CFP. 2212x1659px. 45-degree field of view — 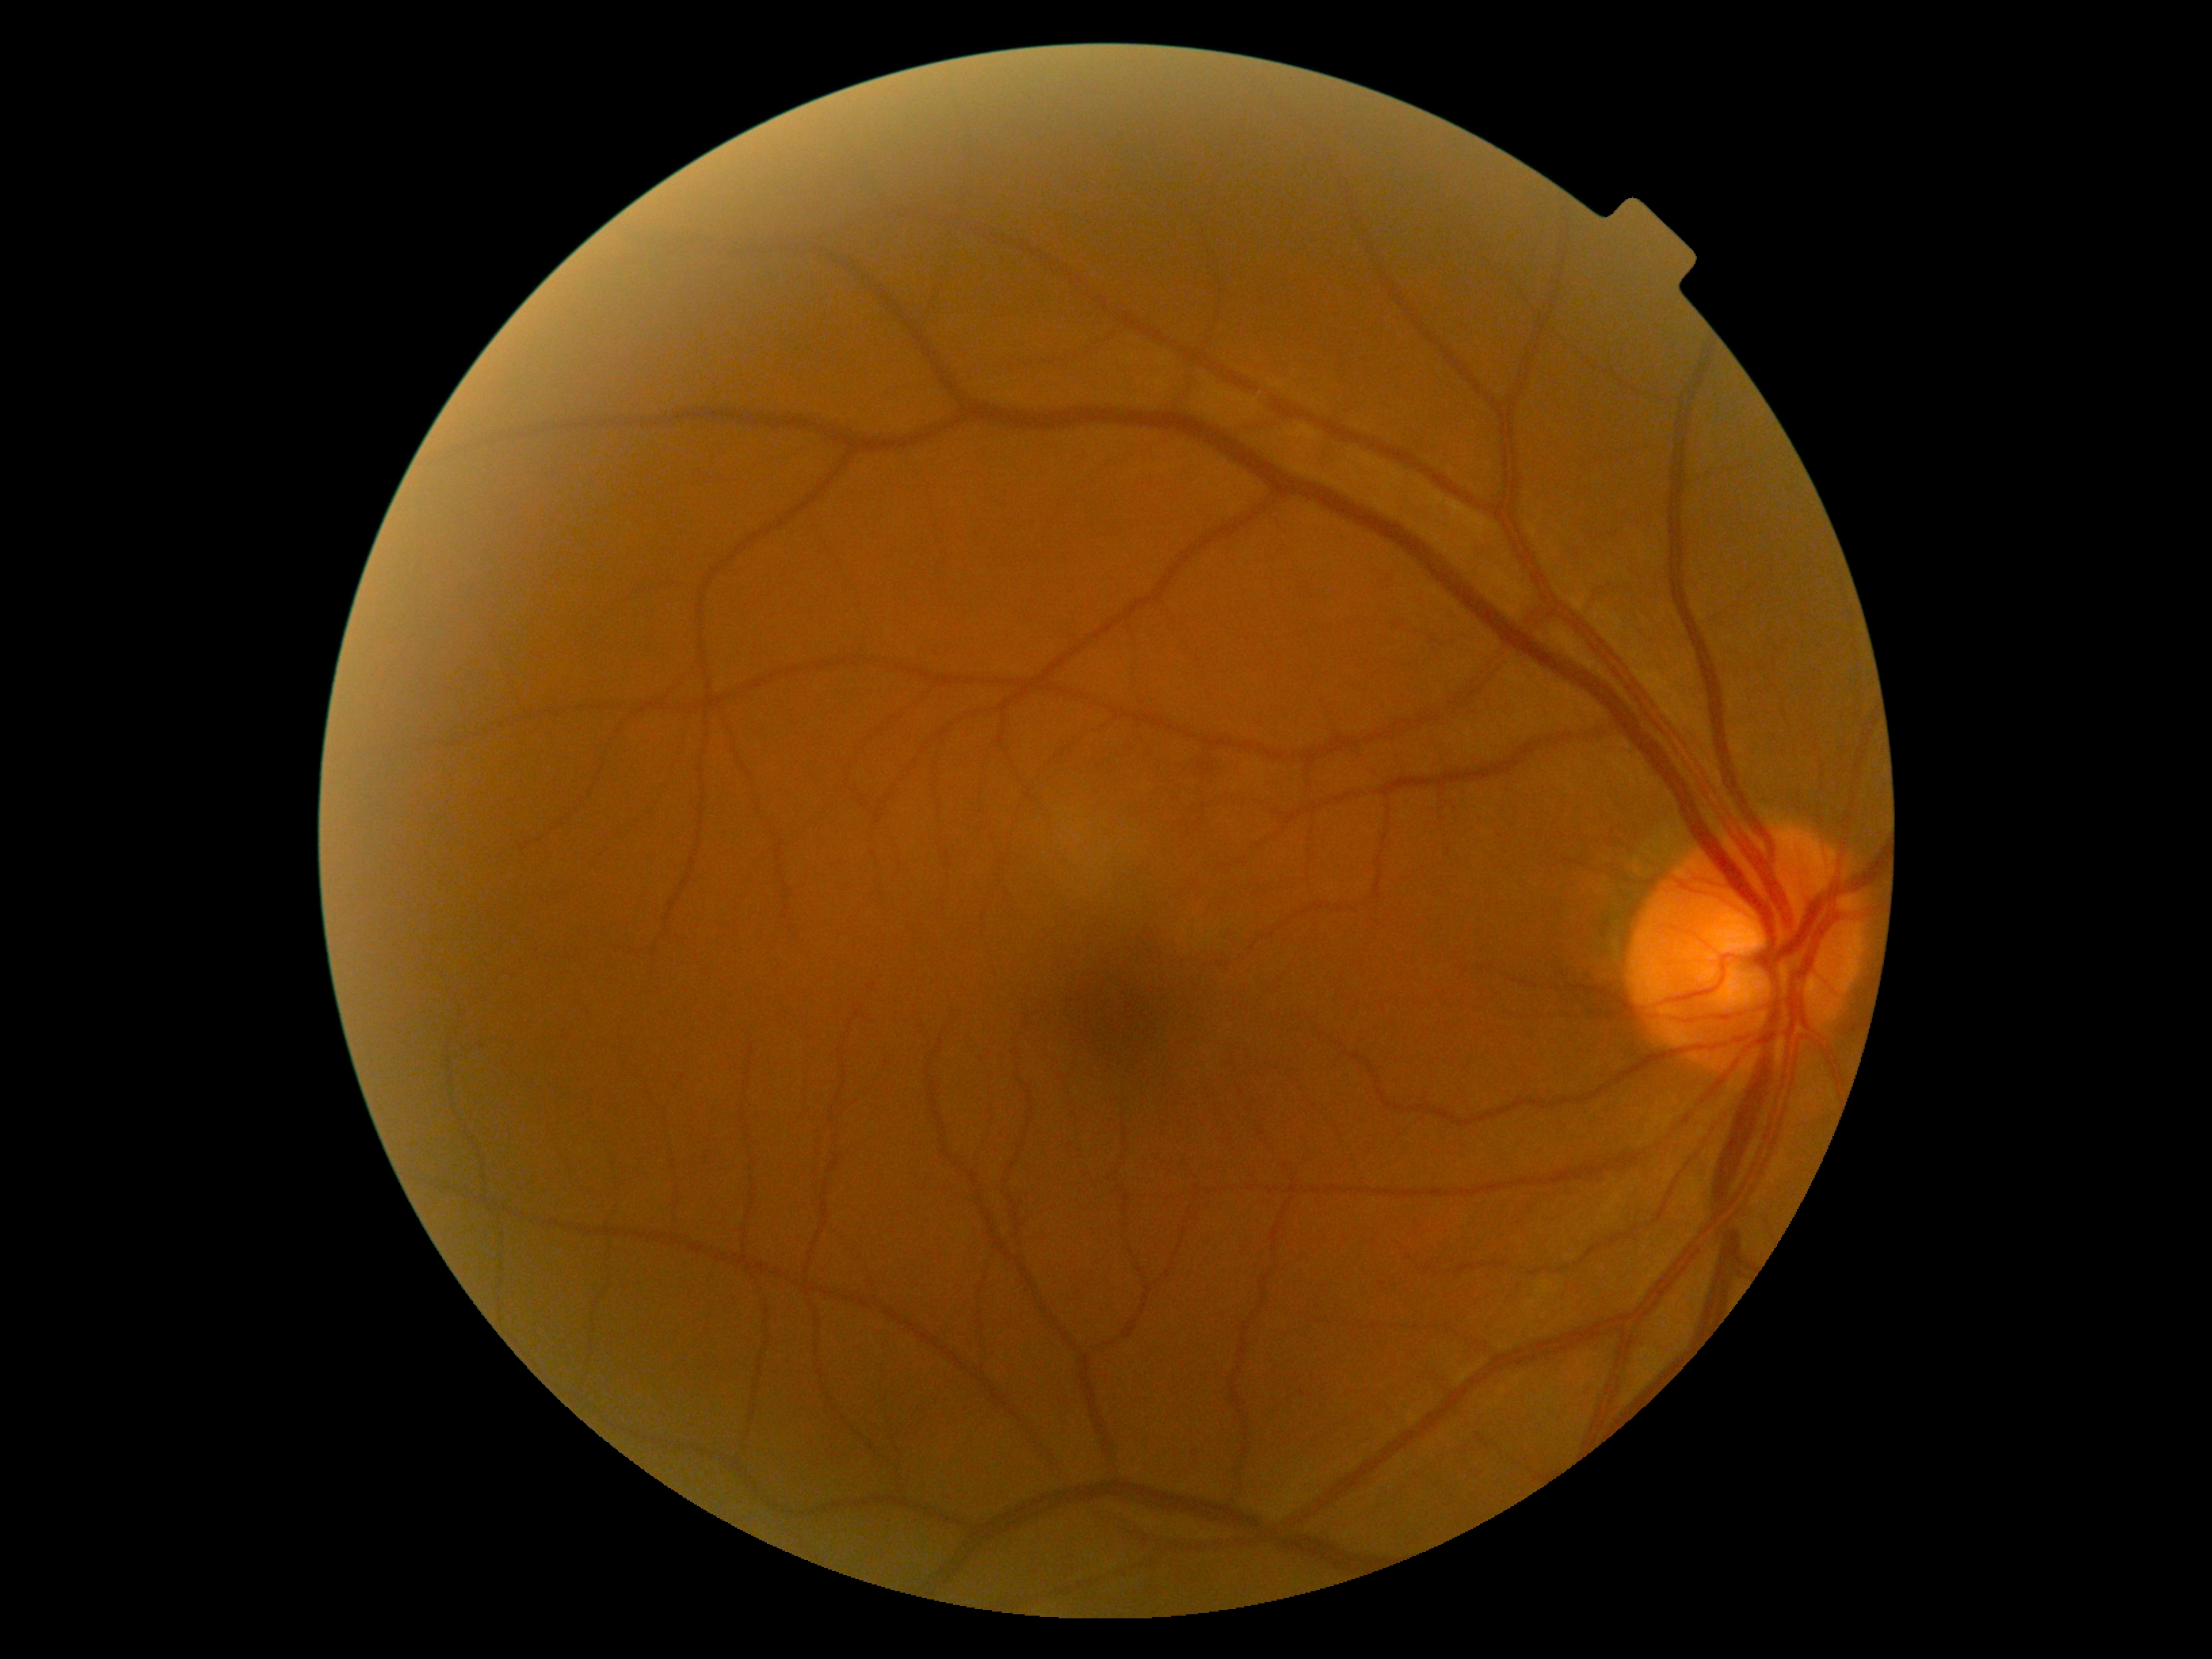

Findings:
– diabetic retinopathy severity — 0/4